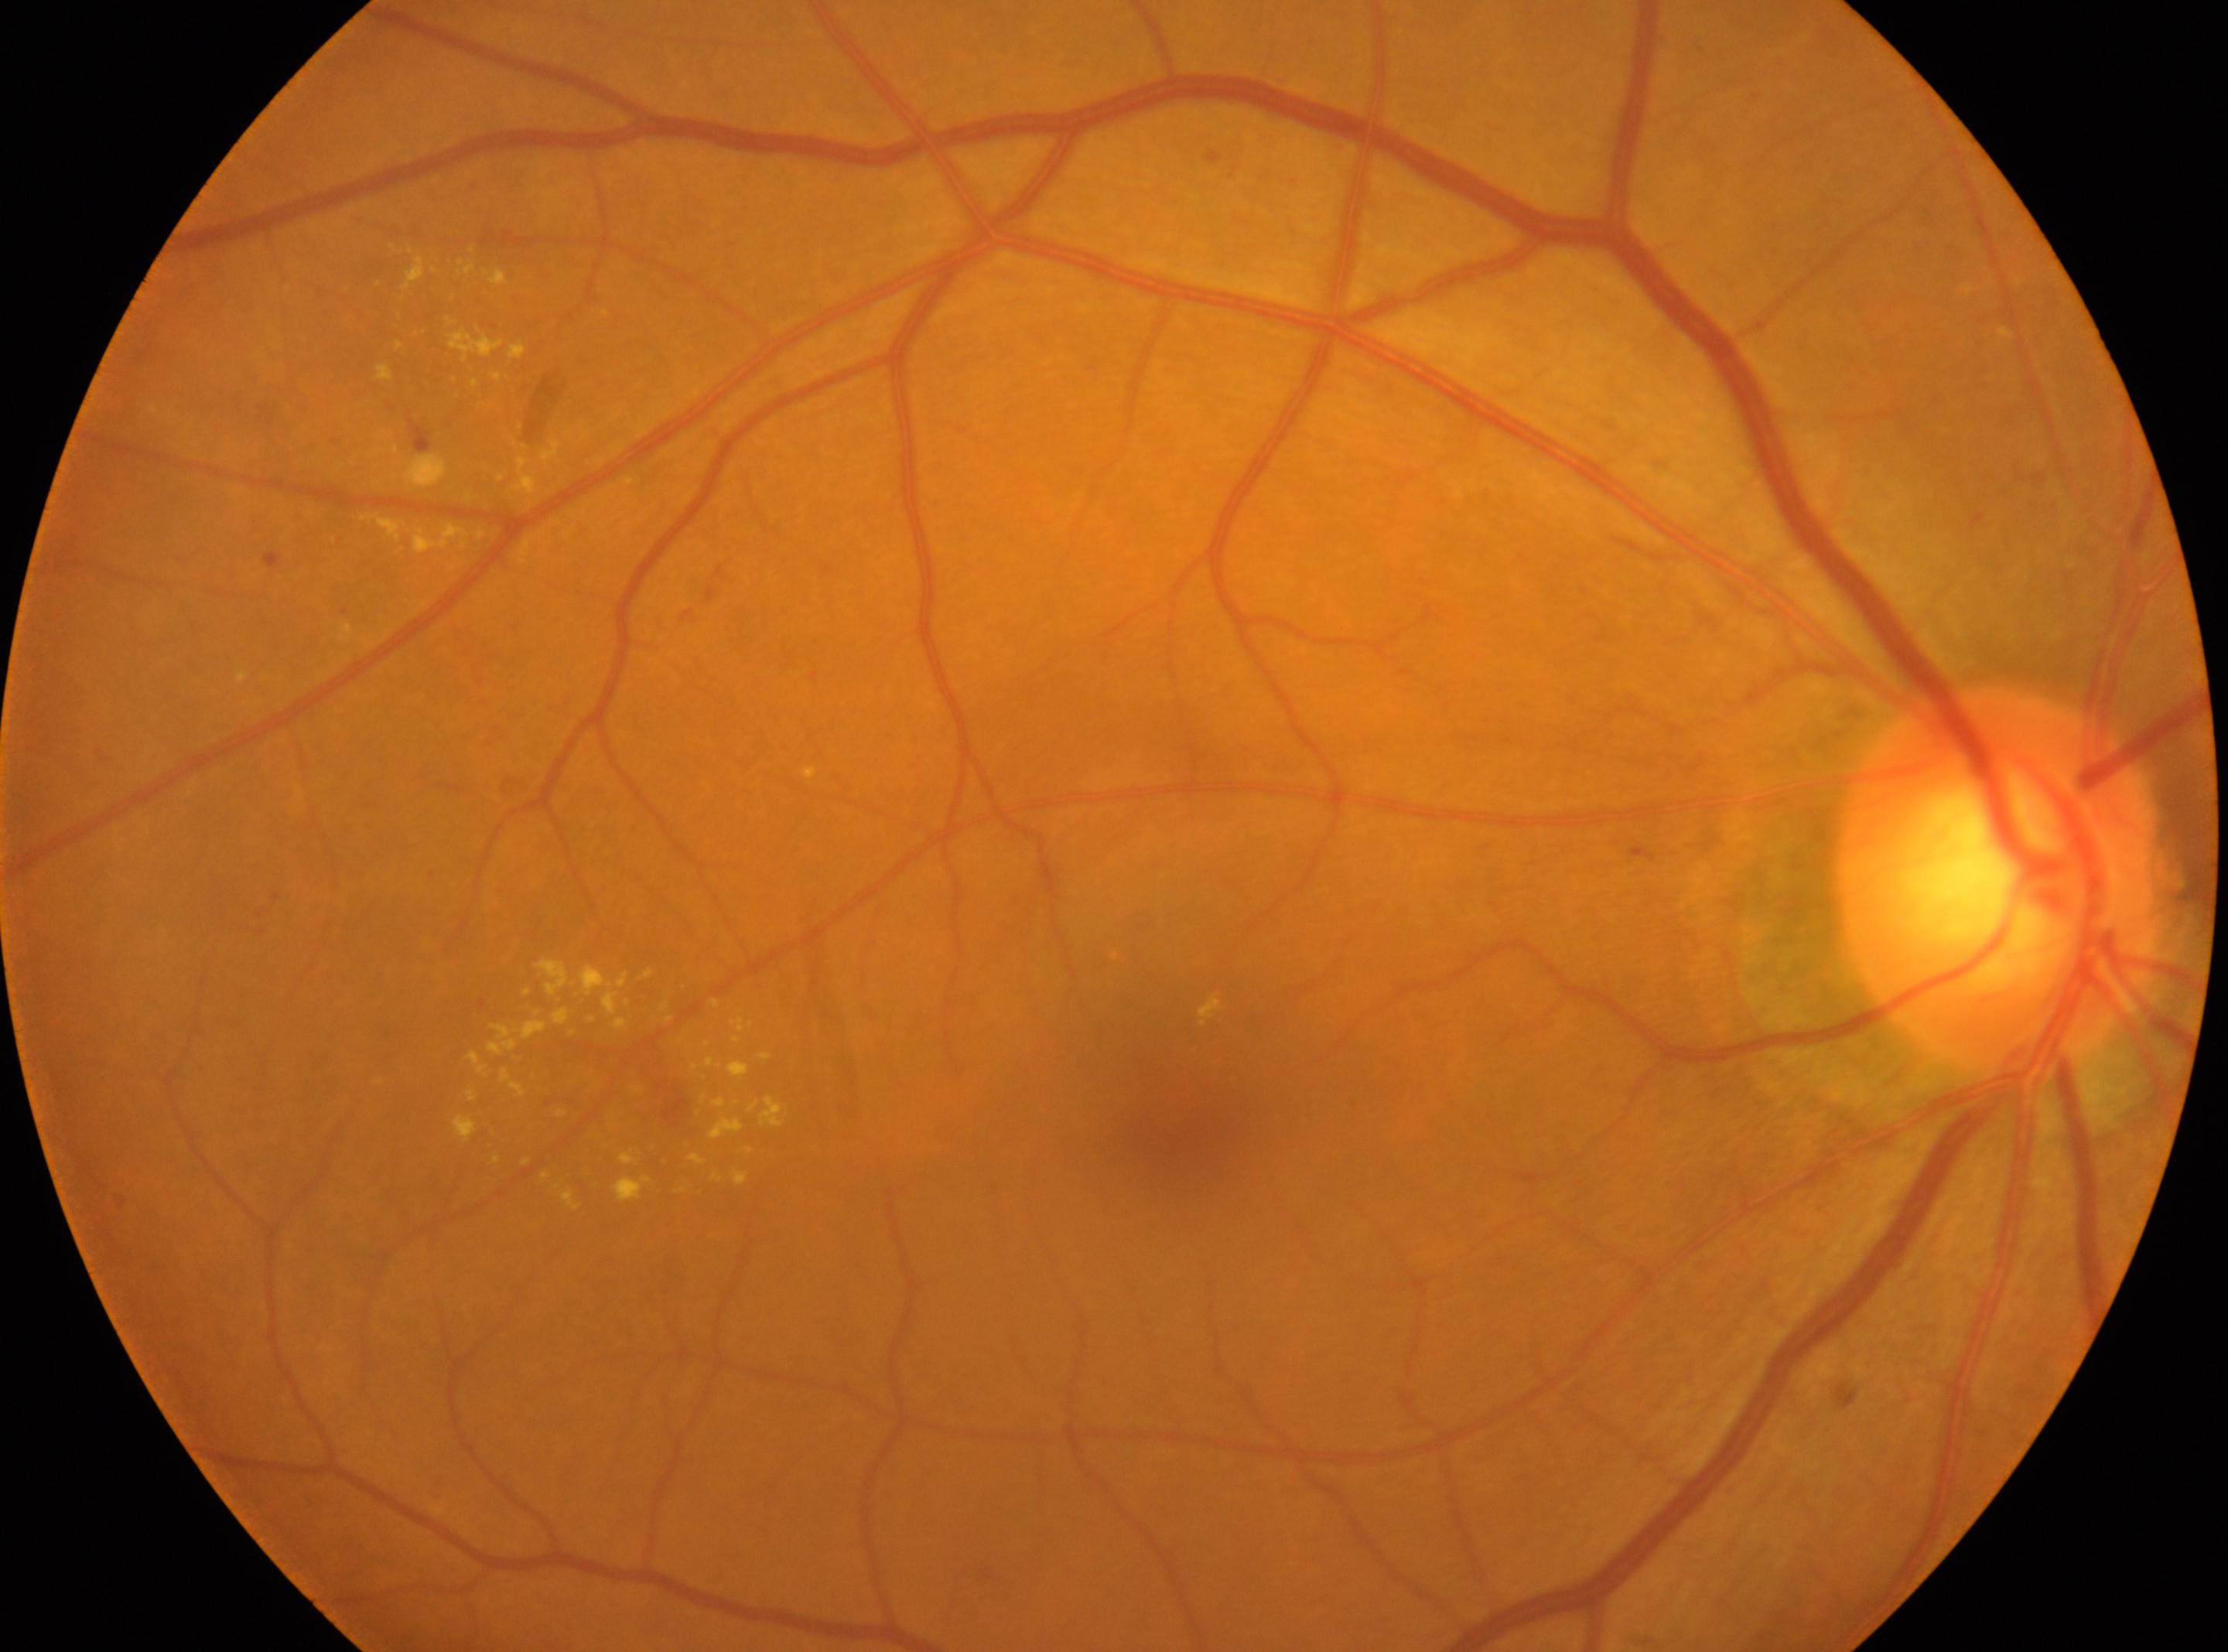
Macular center: (1184,1115).
DR grade: moderate non-proliferative diabetic retinopathy (2).
Eye: right.
The optic disk is at (1998,882).